848x848px
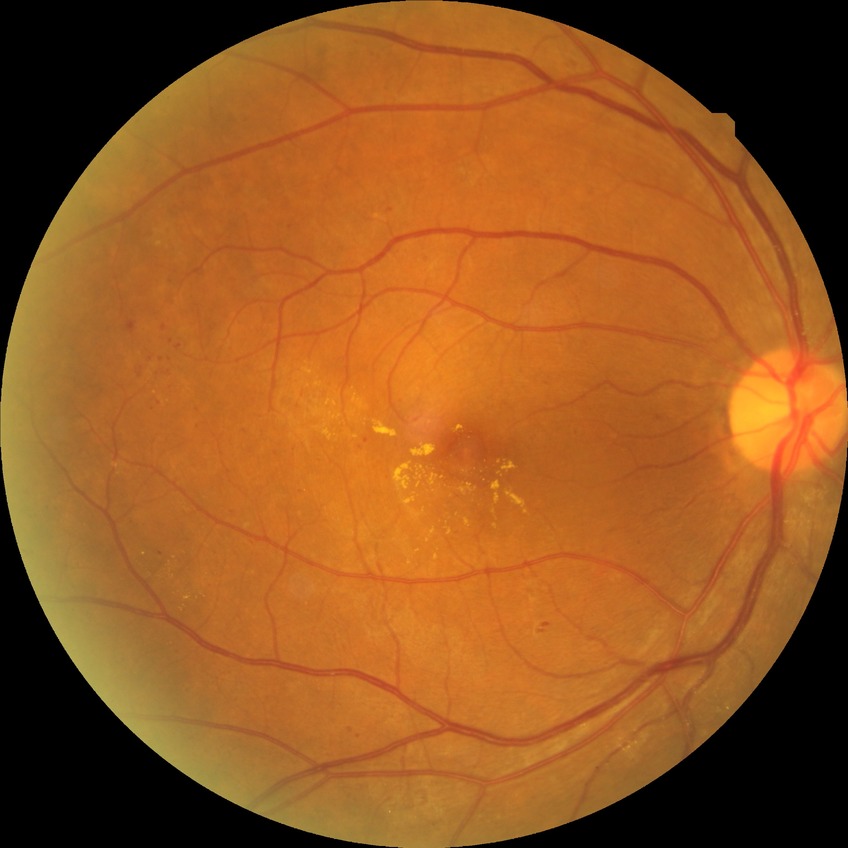
Diabetic retinopathy stage: simple diabetic retinopathy.